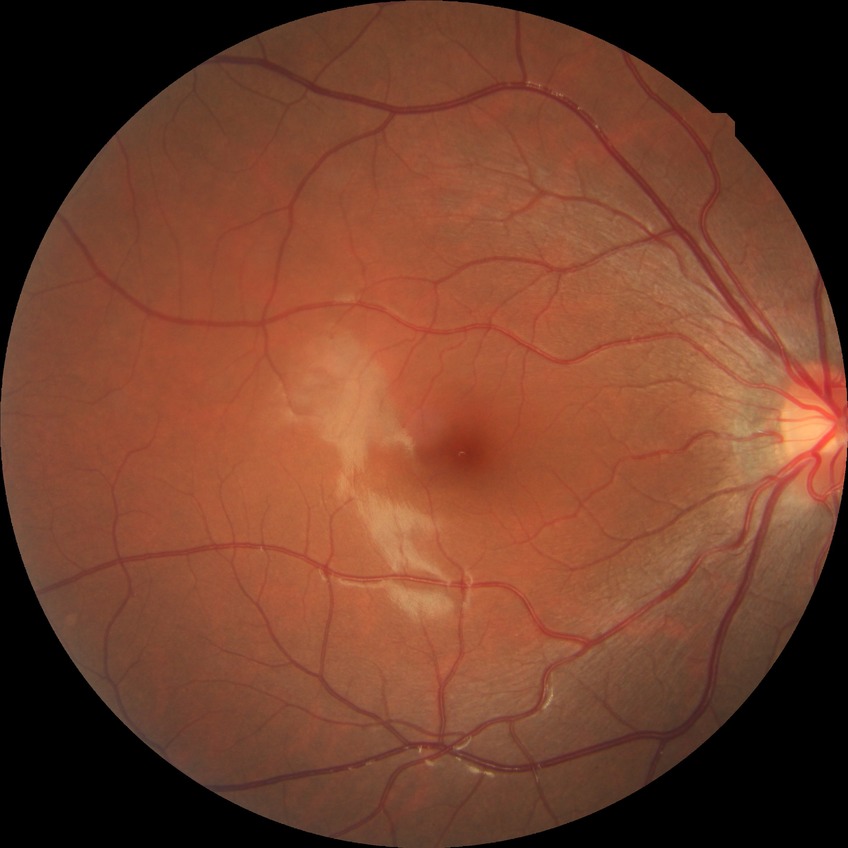

Diabetic retinopathy (DR): no diabetic retinopathy (NDR).